Camera: Nidek AFC-330, optic disc-centered crop, captured without pupil dilation:
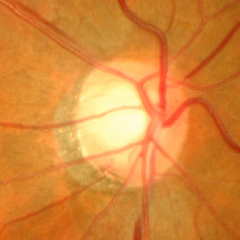 Fundus appearance consistent with advanced-stage glaucoma.